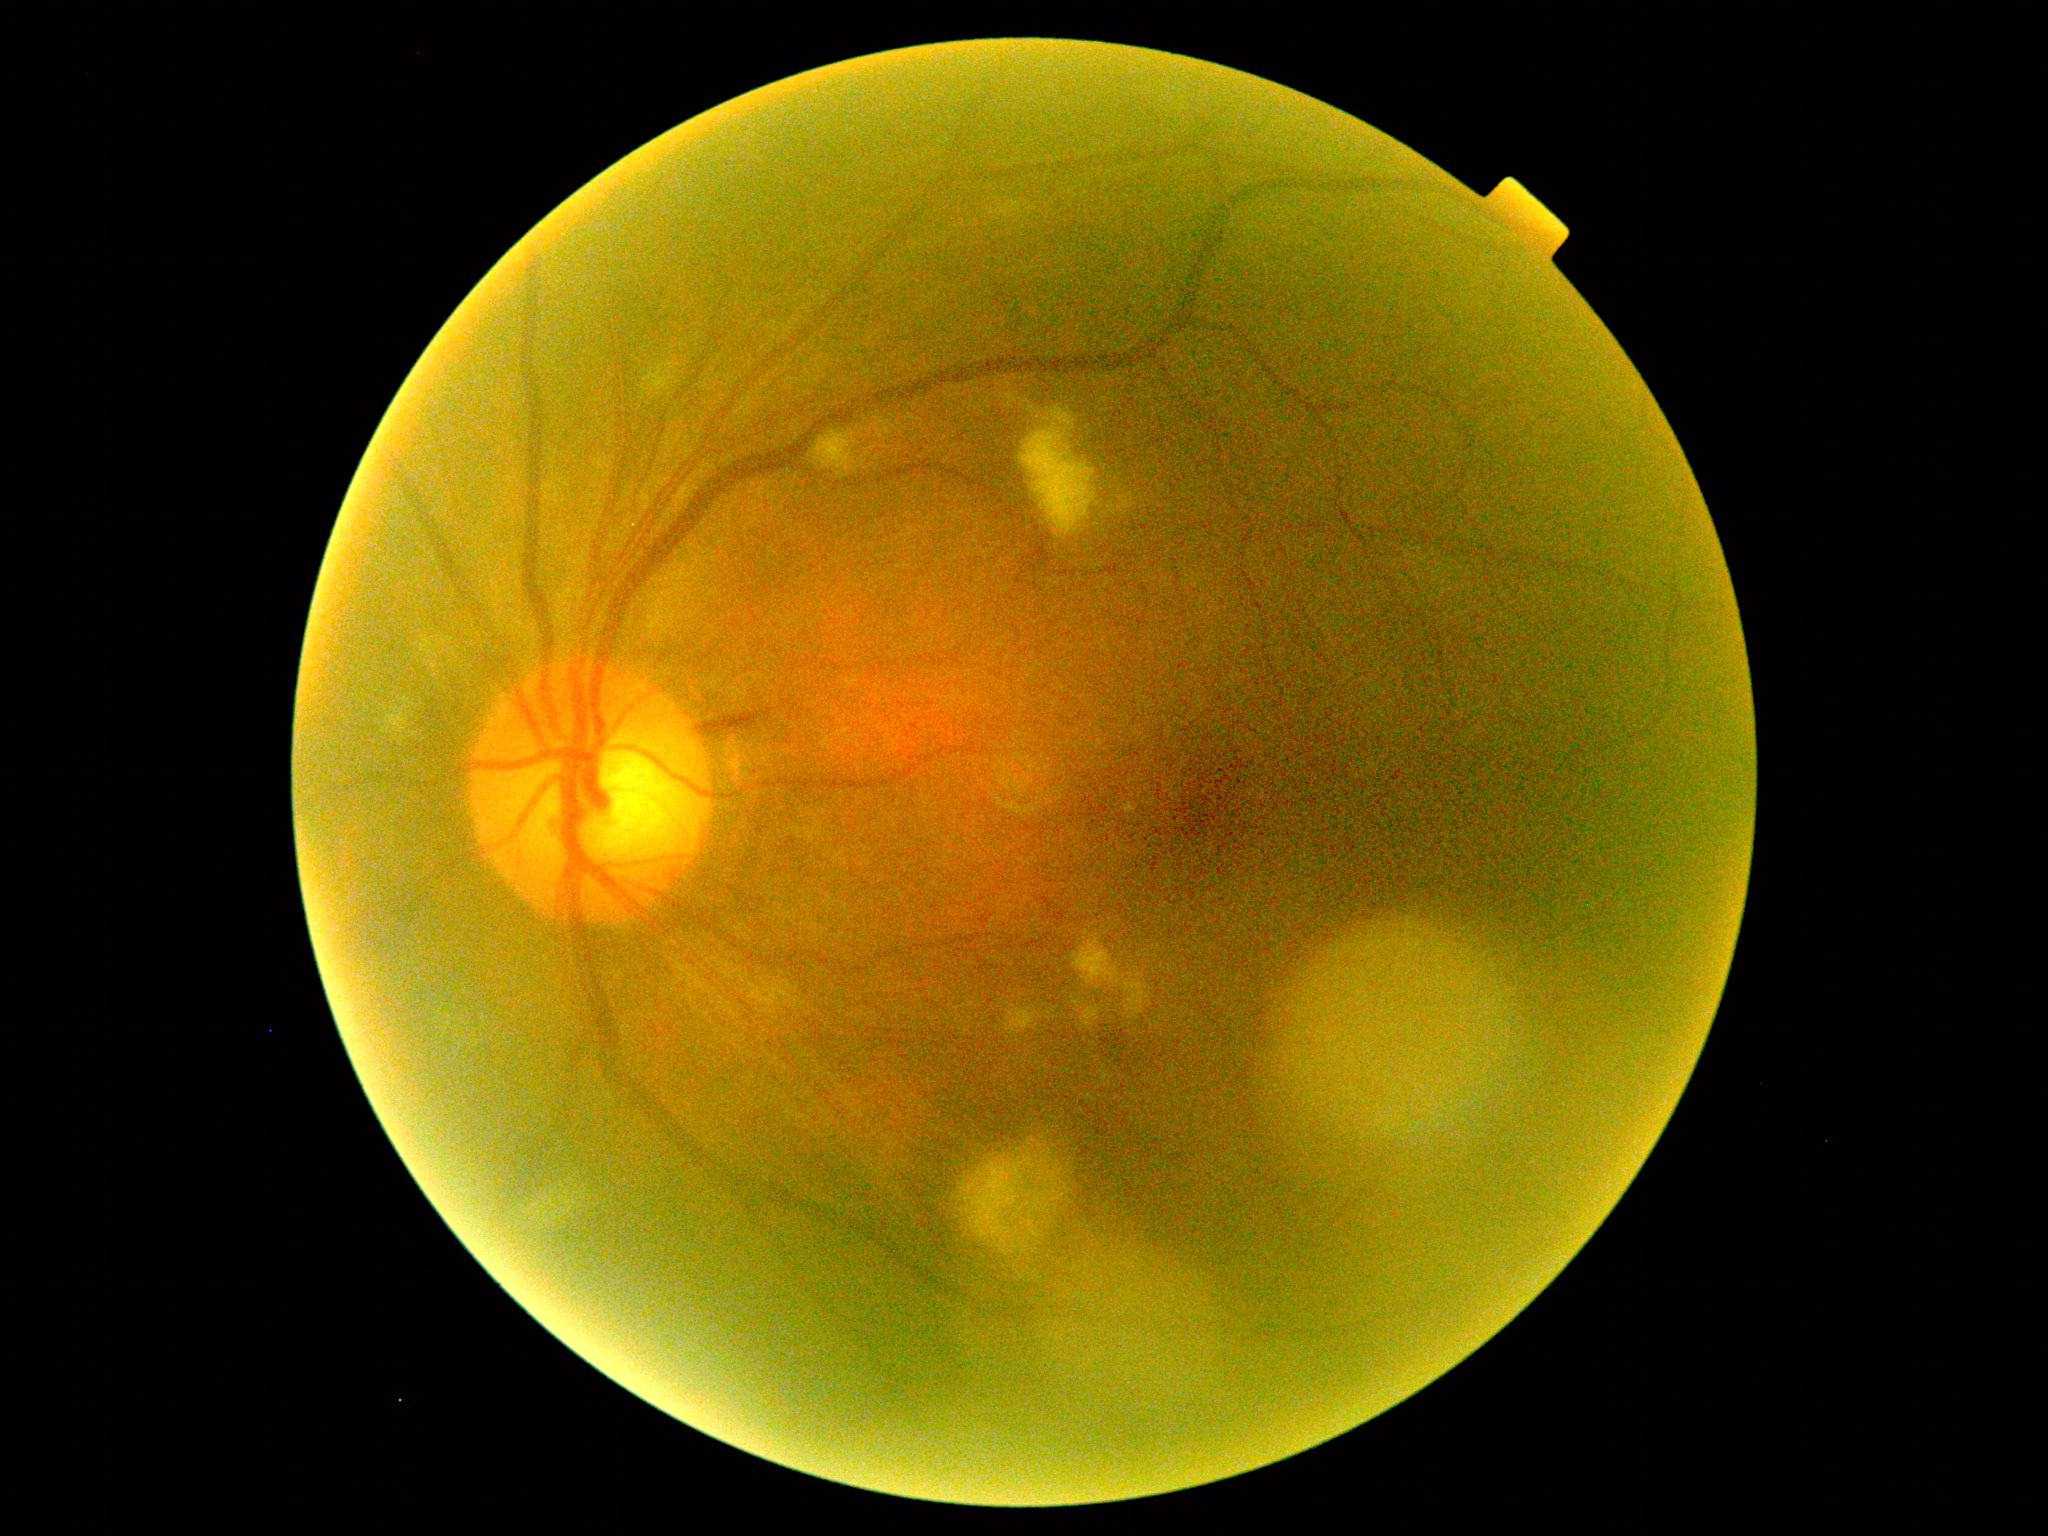
  dr_grade: moderate non-proliferative diabetic retinopathy (grade 2)